Nidek AFC-330. Retinal fundus photograph
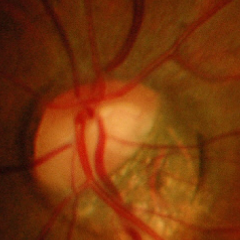
Findings consistent with advanced glaucomatous optic neuropathy.